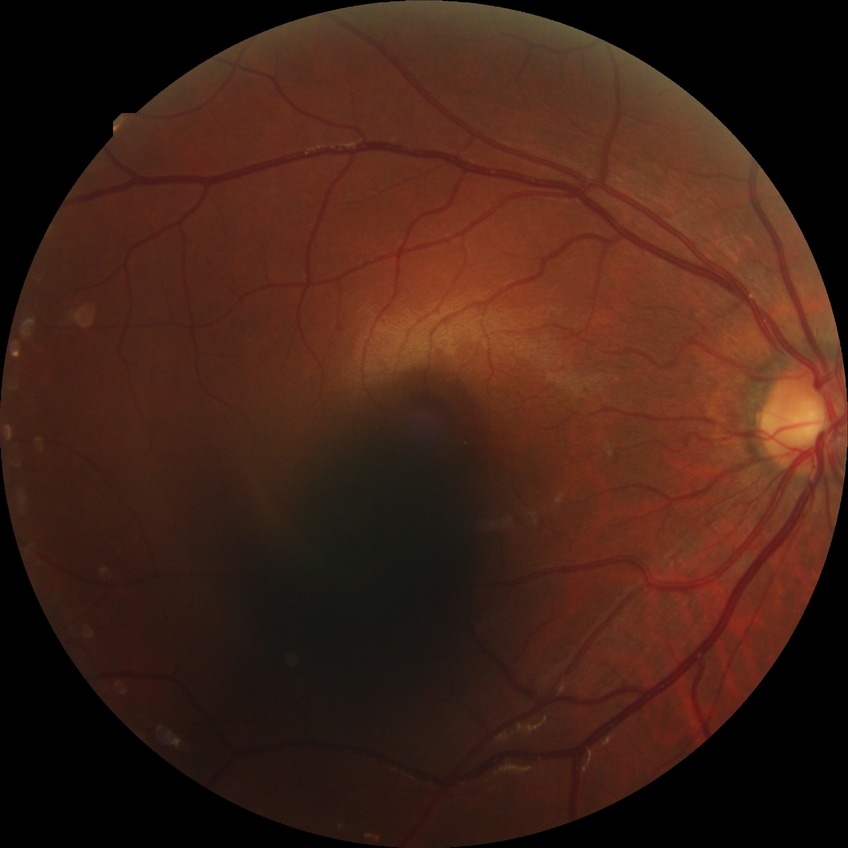

Diabetic retinopathy (DR): simple diabetic retinopathy (SDR).
The retinopathy is classified as non-proliferative diabetic retinopathy.